Retinal fundus photograph — 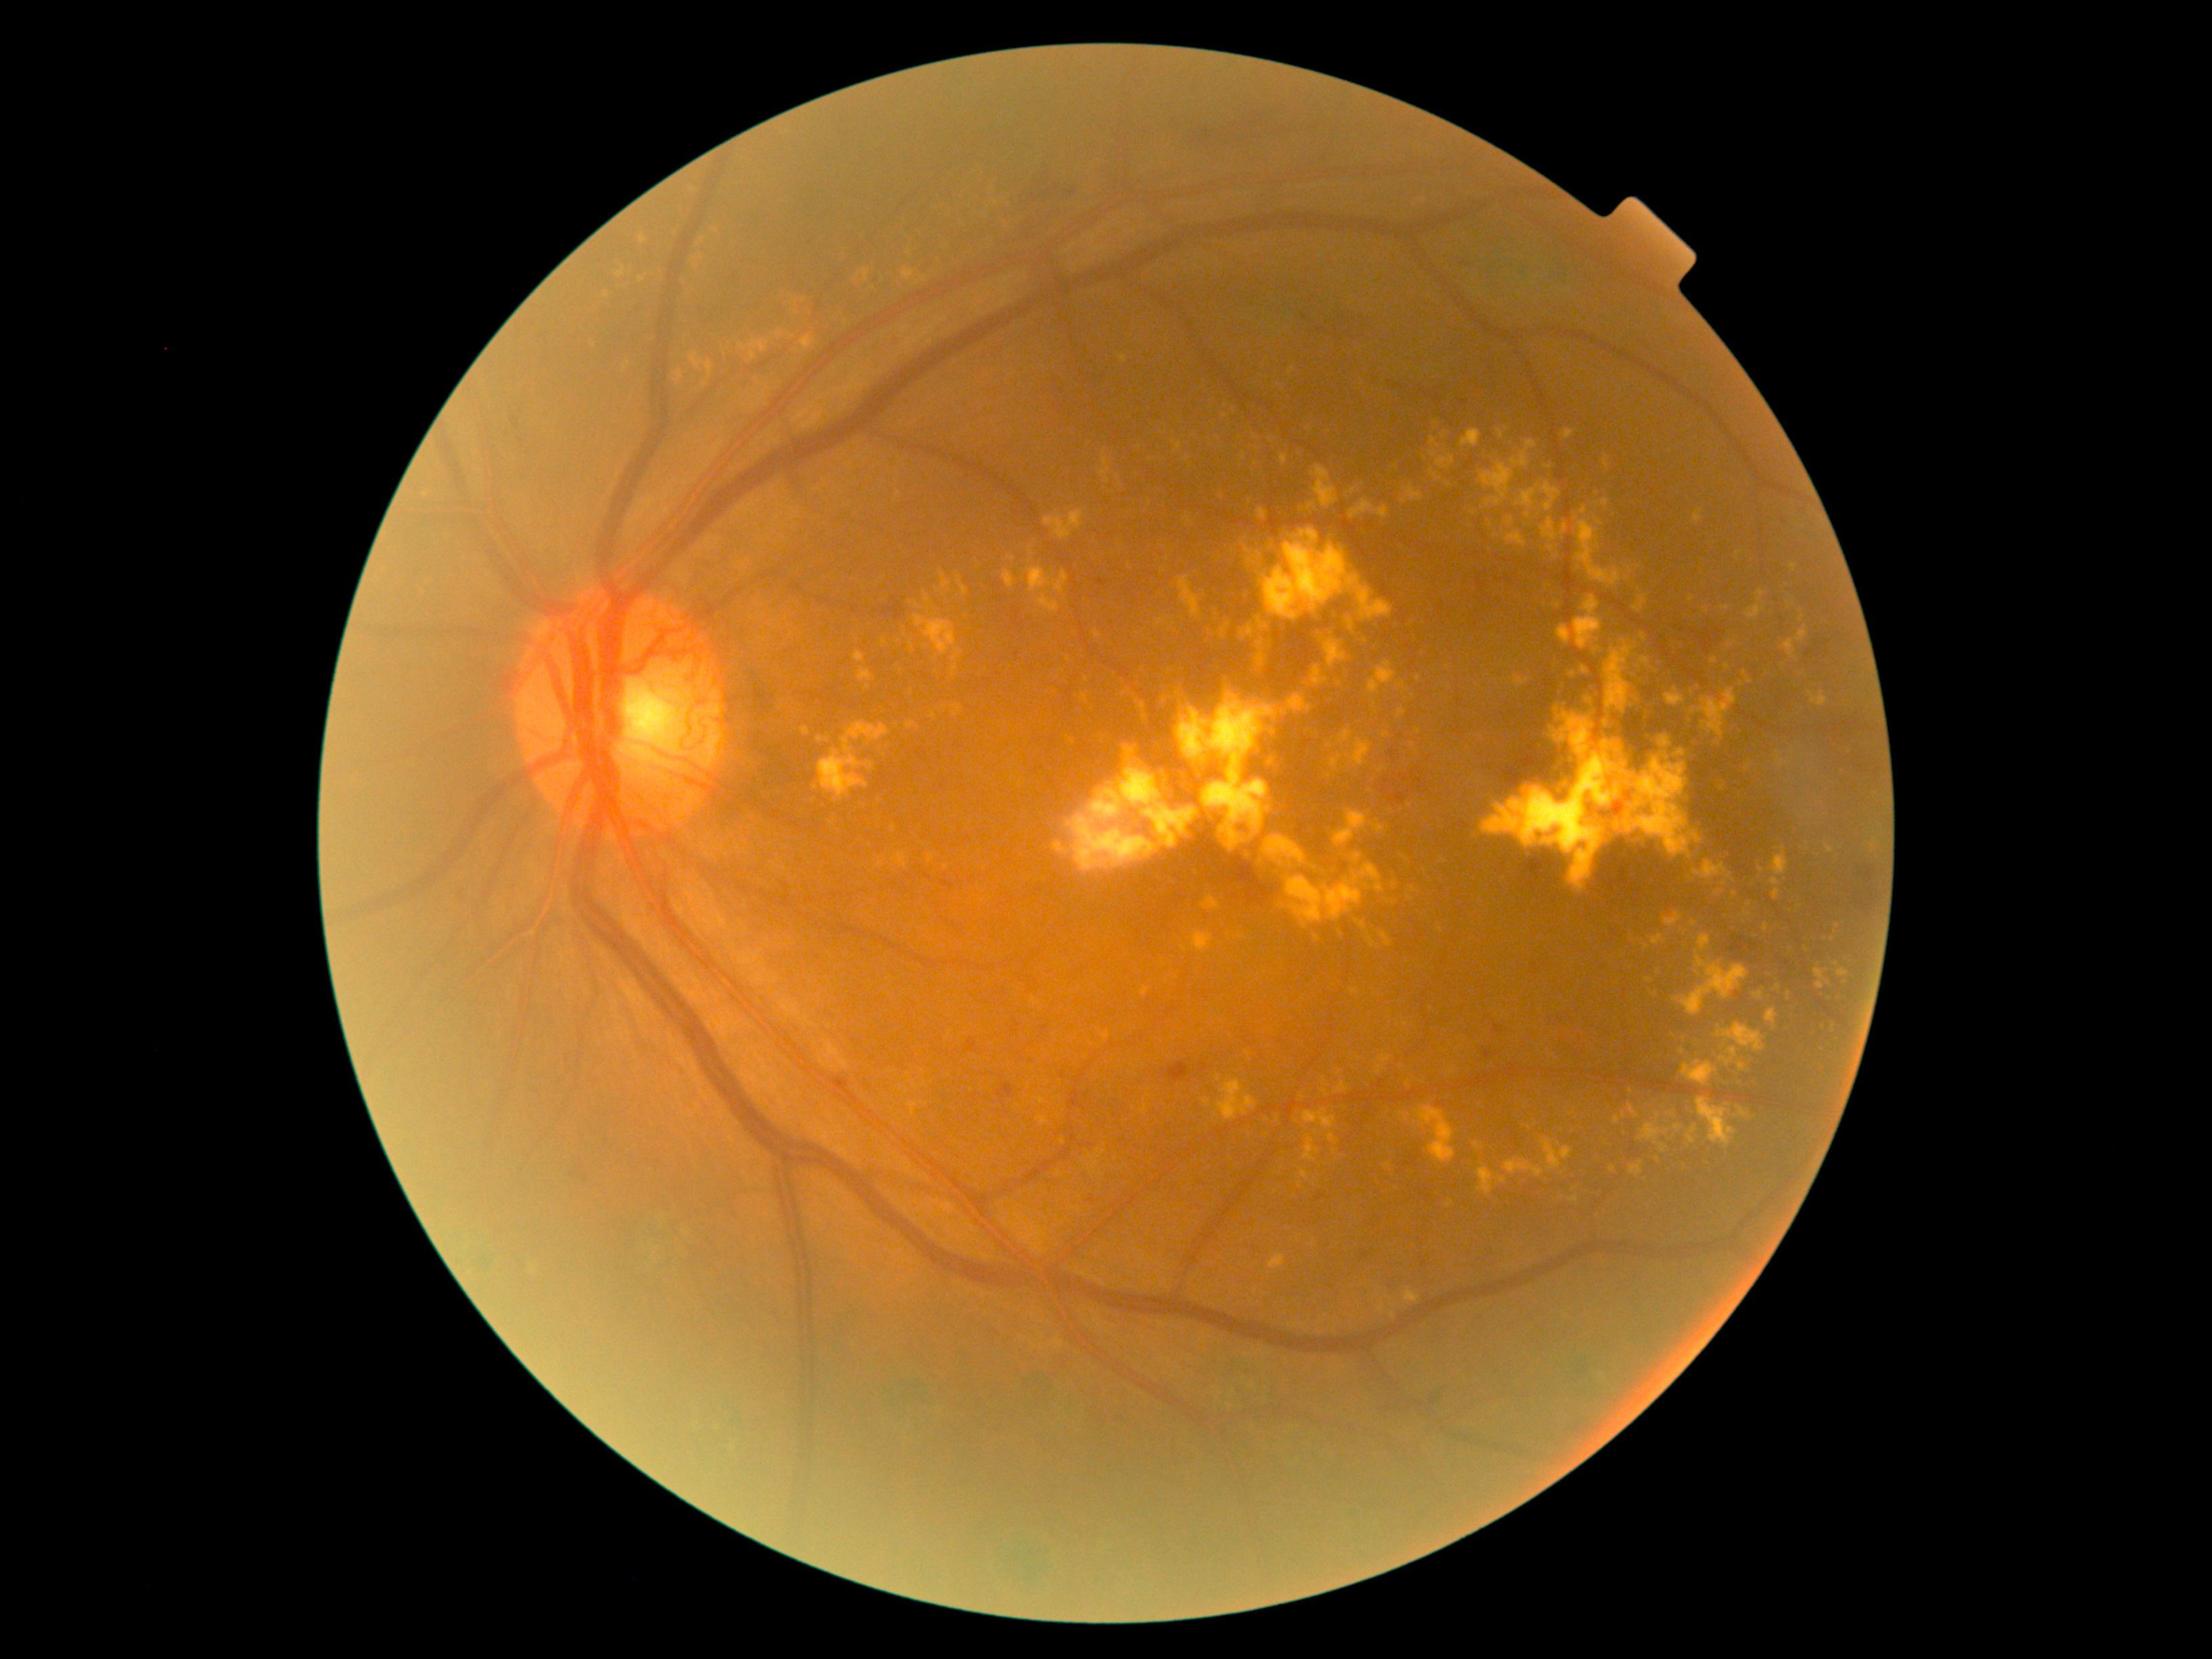

{"partial":true,"dr_grade":4,"lesions":{"ex":[[1616,742,1626,756],[1338,1082,1348,1093],[1562,524,1568,535],[1203,897,1221,910],[1351,989,1359,994],[940,571,949,589],[1303,1109,1337,1128],[1719,1043,1738,1061],[1397,859,1405,867],[1218,1080,1256,1122],[1572,560,1577,575],[1719,855,1732,859],[1605,1135,1610,1143]],"ex_small":[[625,371],[1739,553],[1363,925],[1033,546],[1735,1116],[1636,645],[1750,915]]}}